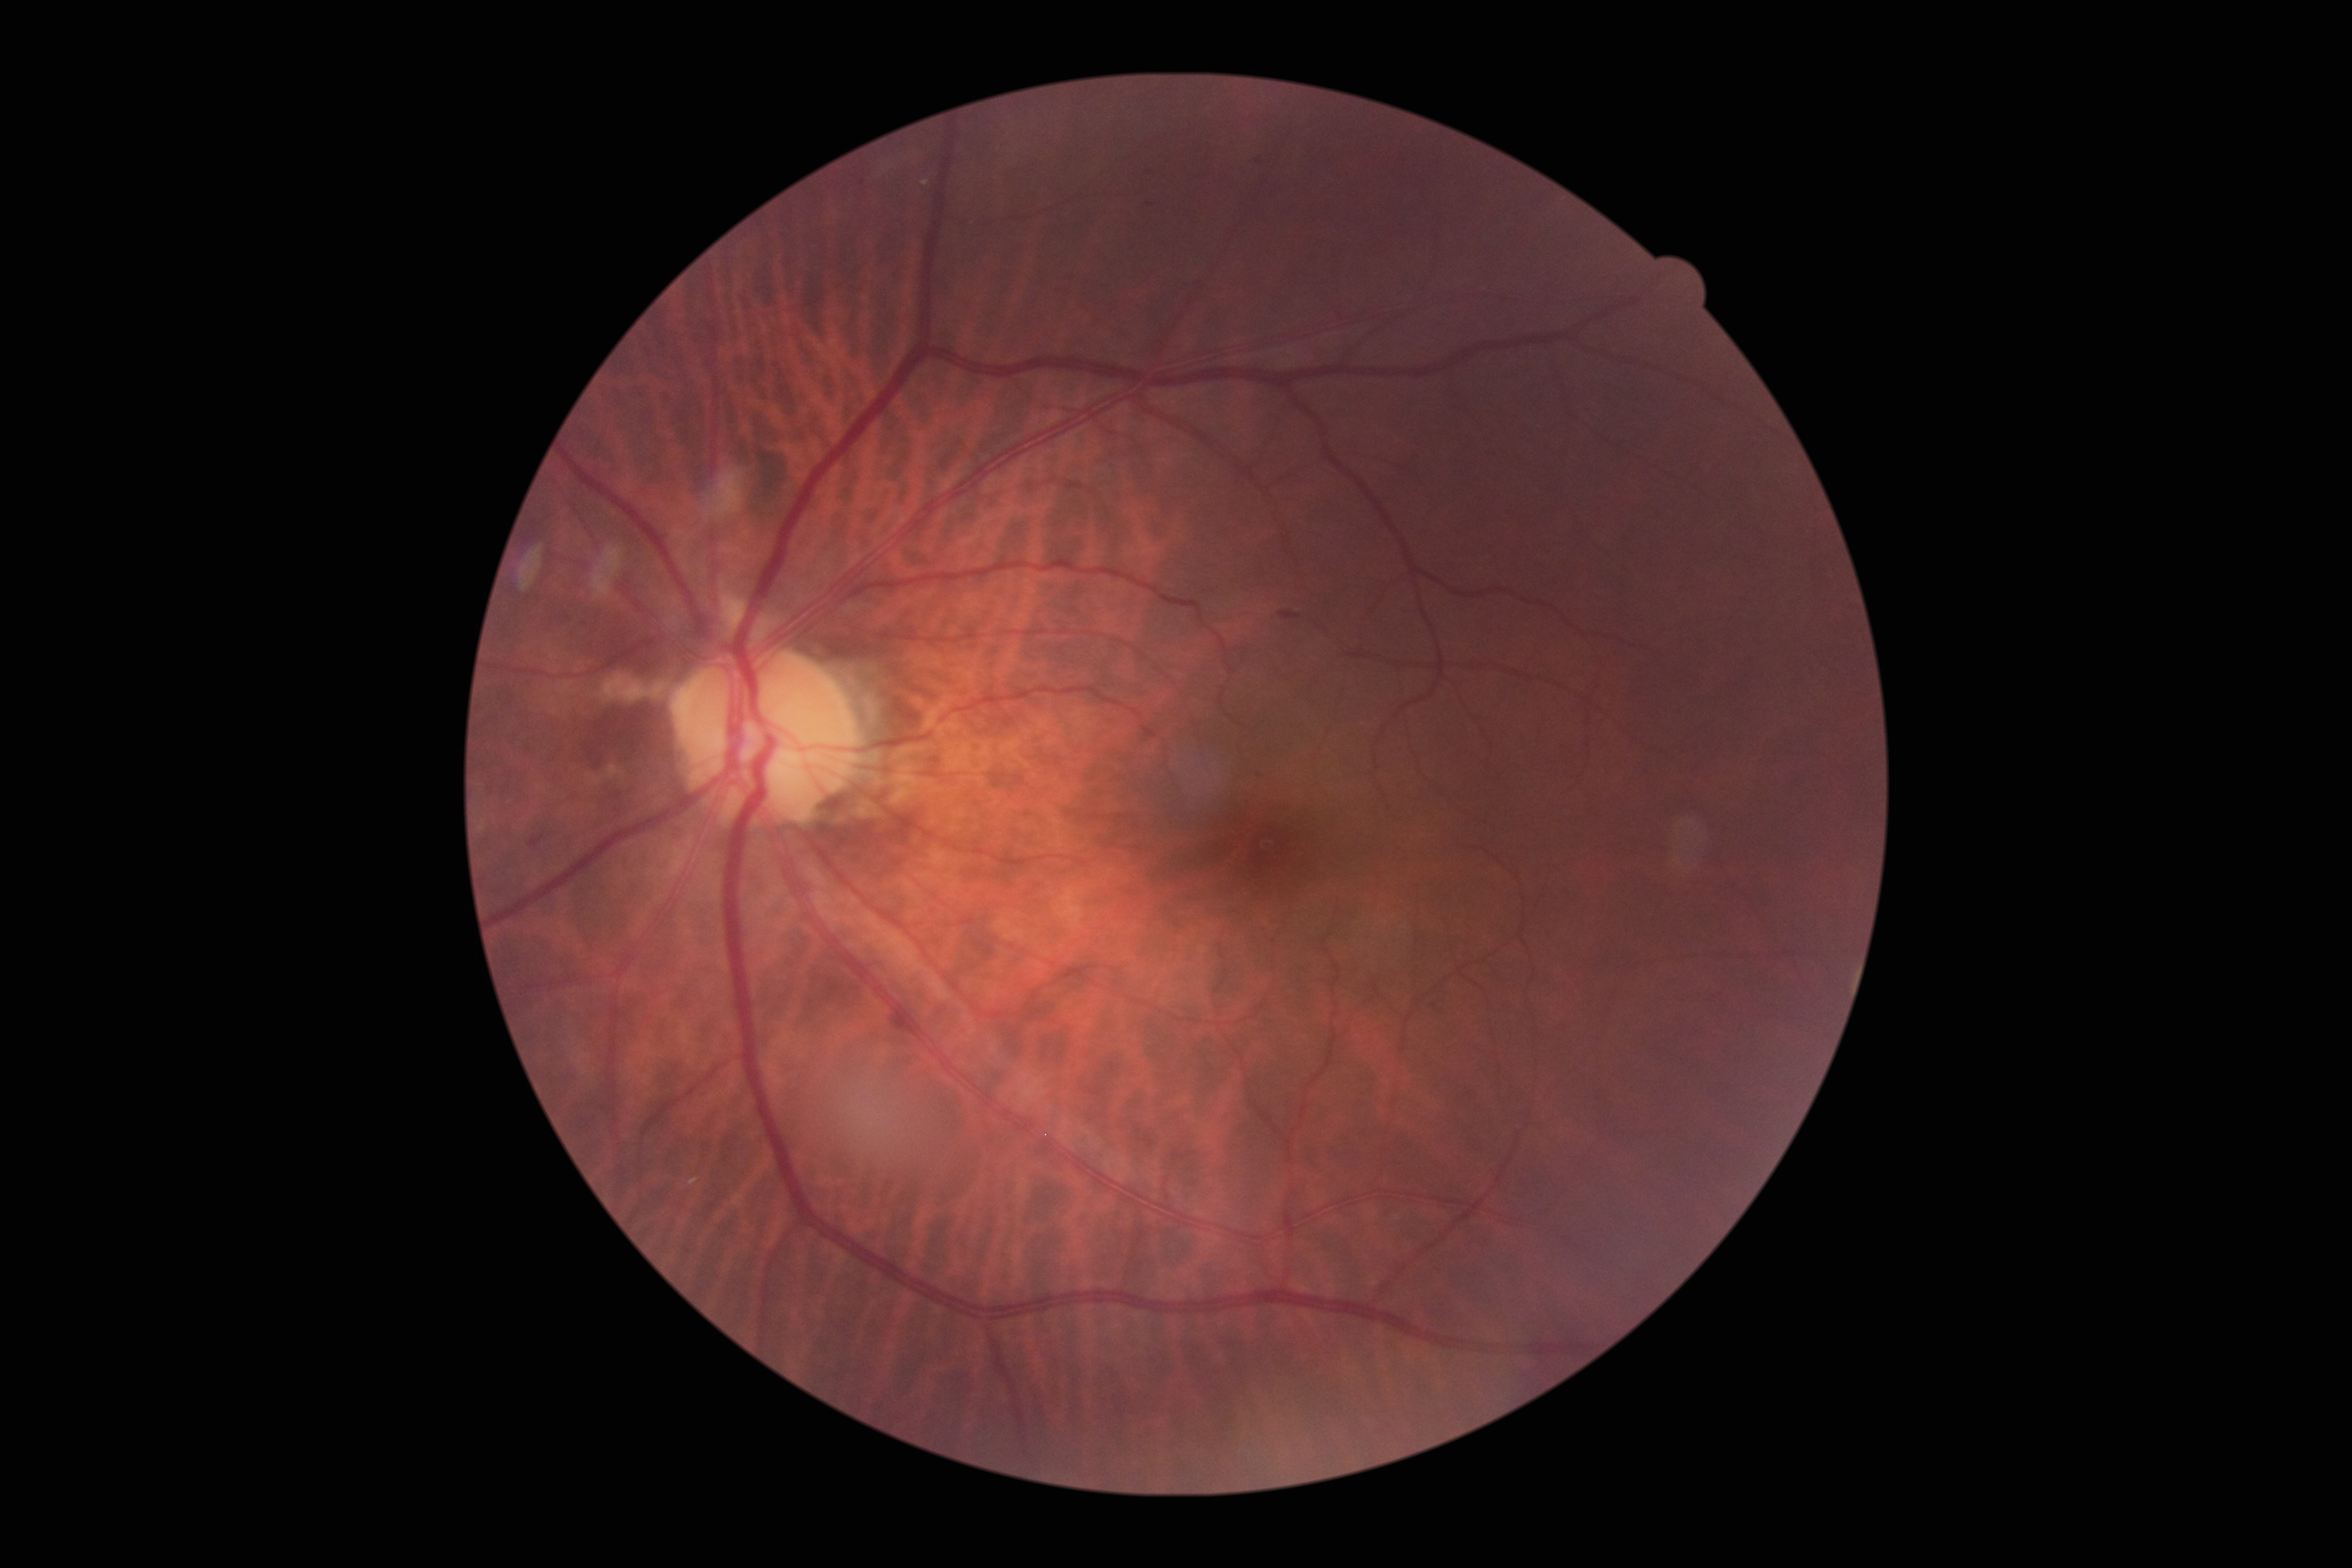 DR grade is 2/4.
DR class: non-proliferative diabetic retinopathy.